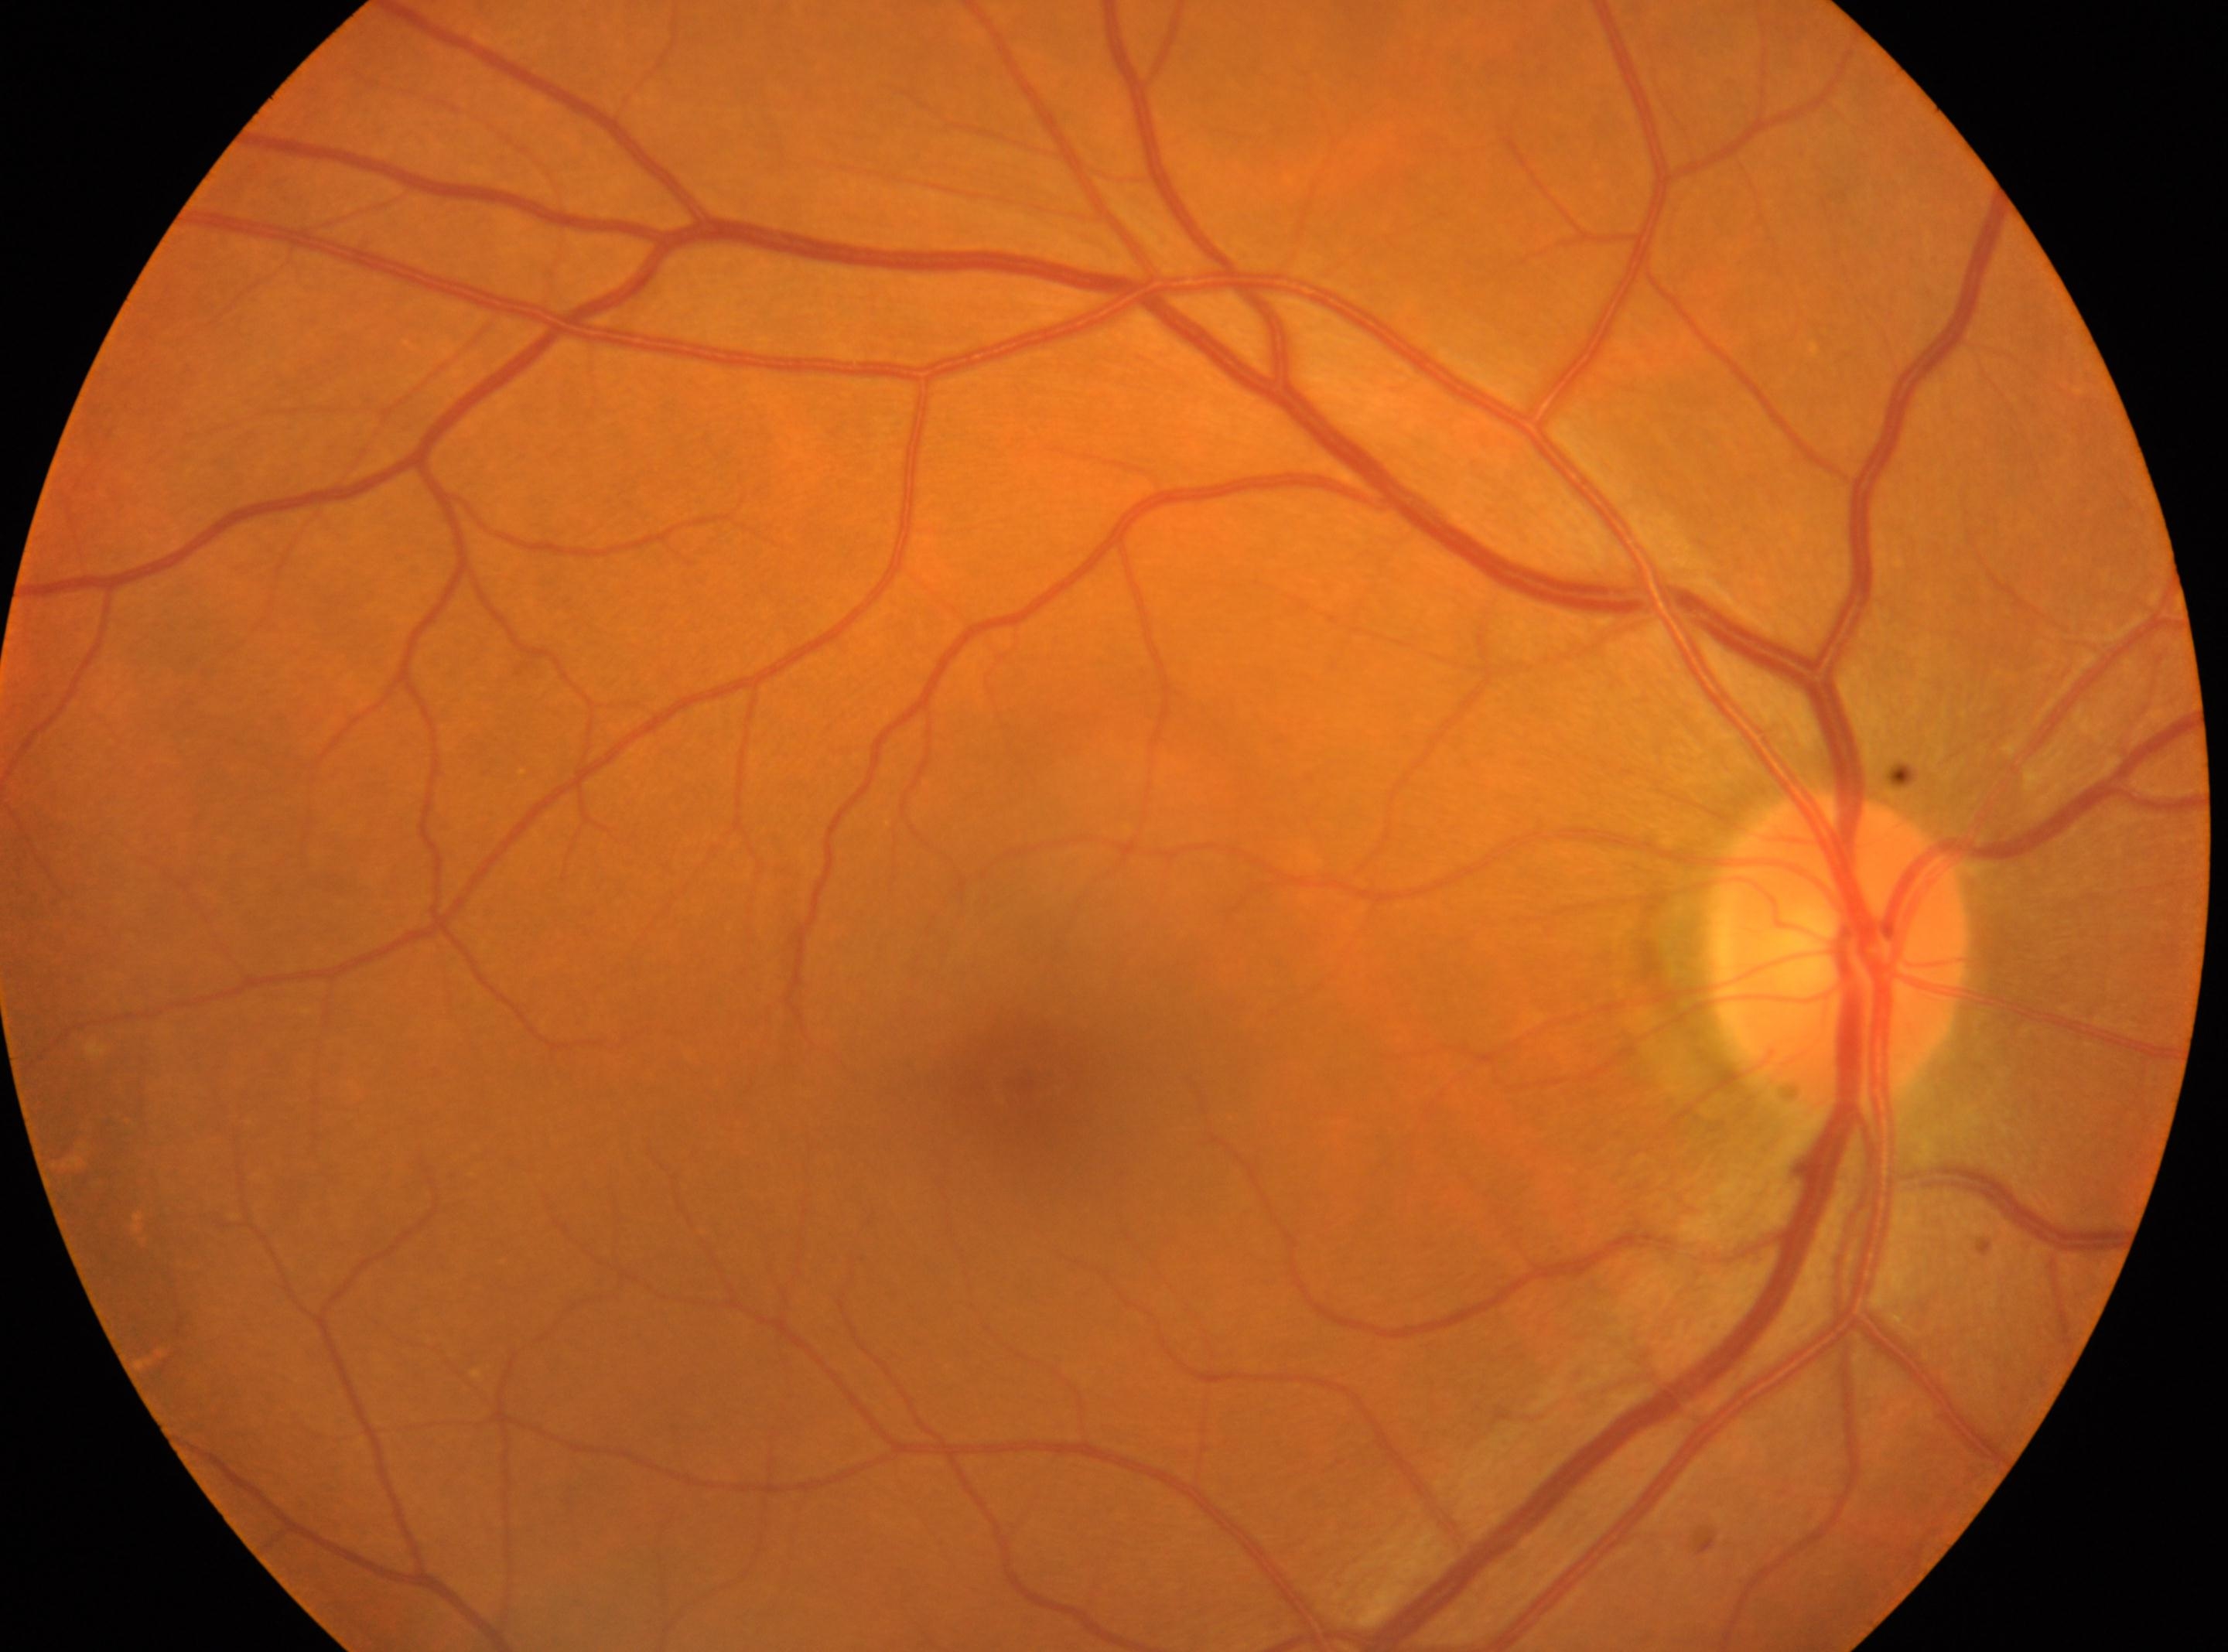
Findings:
• ONH — (x=1840, y=950)
• fovea — (x=1015, y=1091)
• DR severity — 0
• laterality — right